Portable fundus camera image — 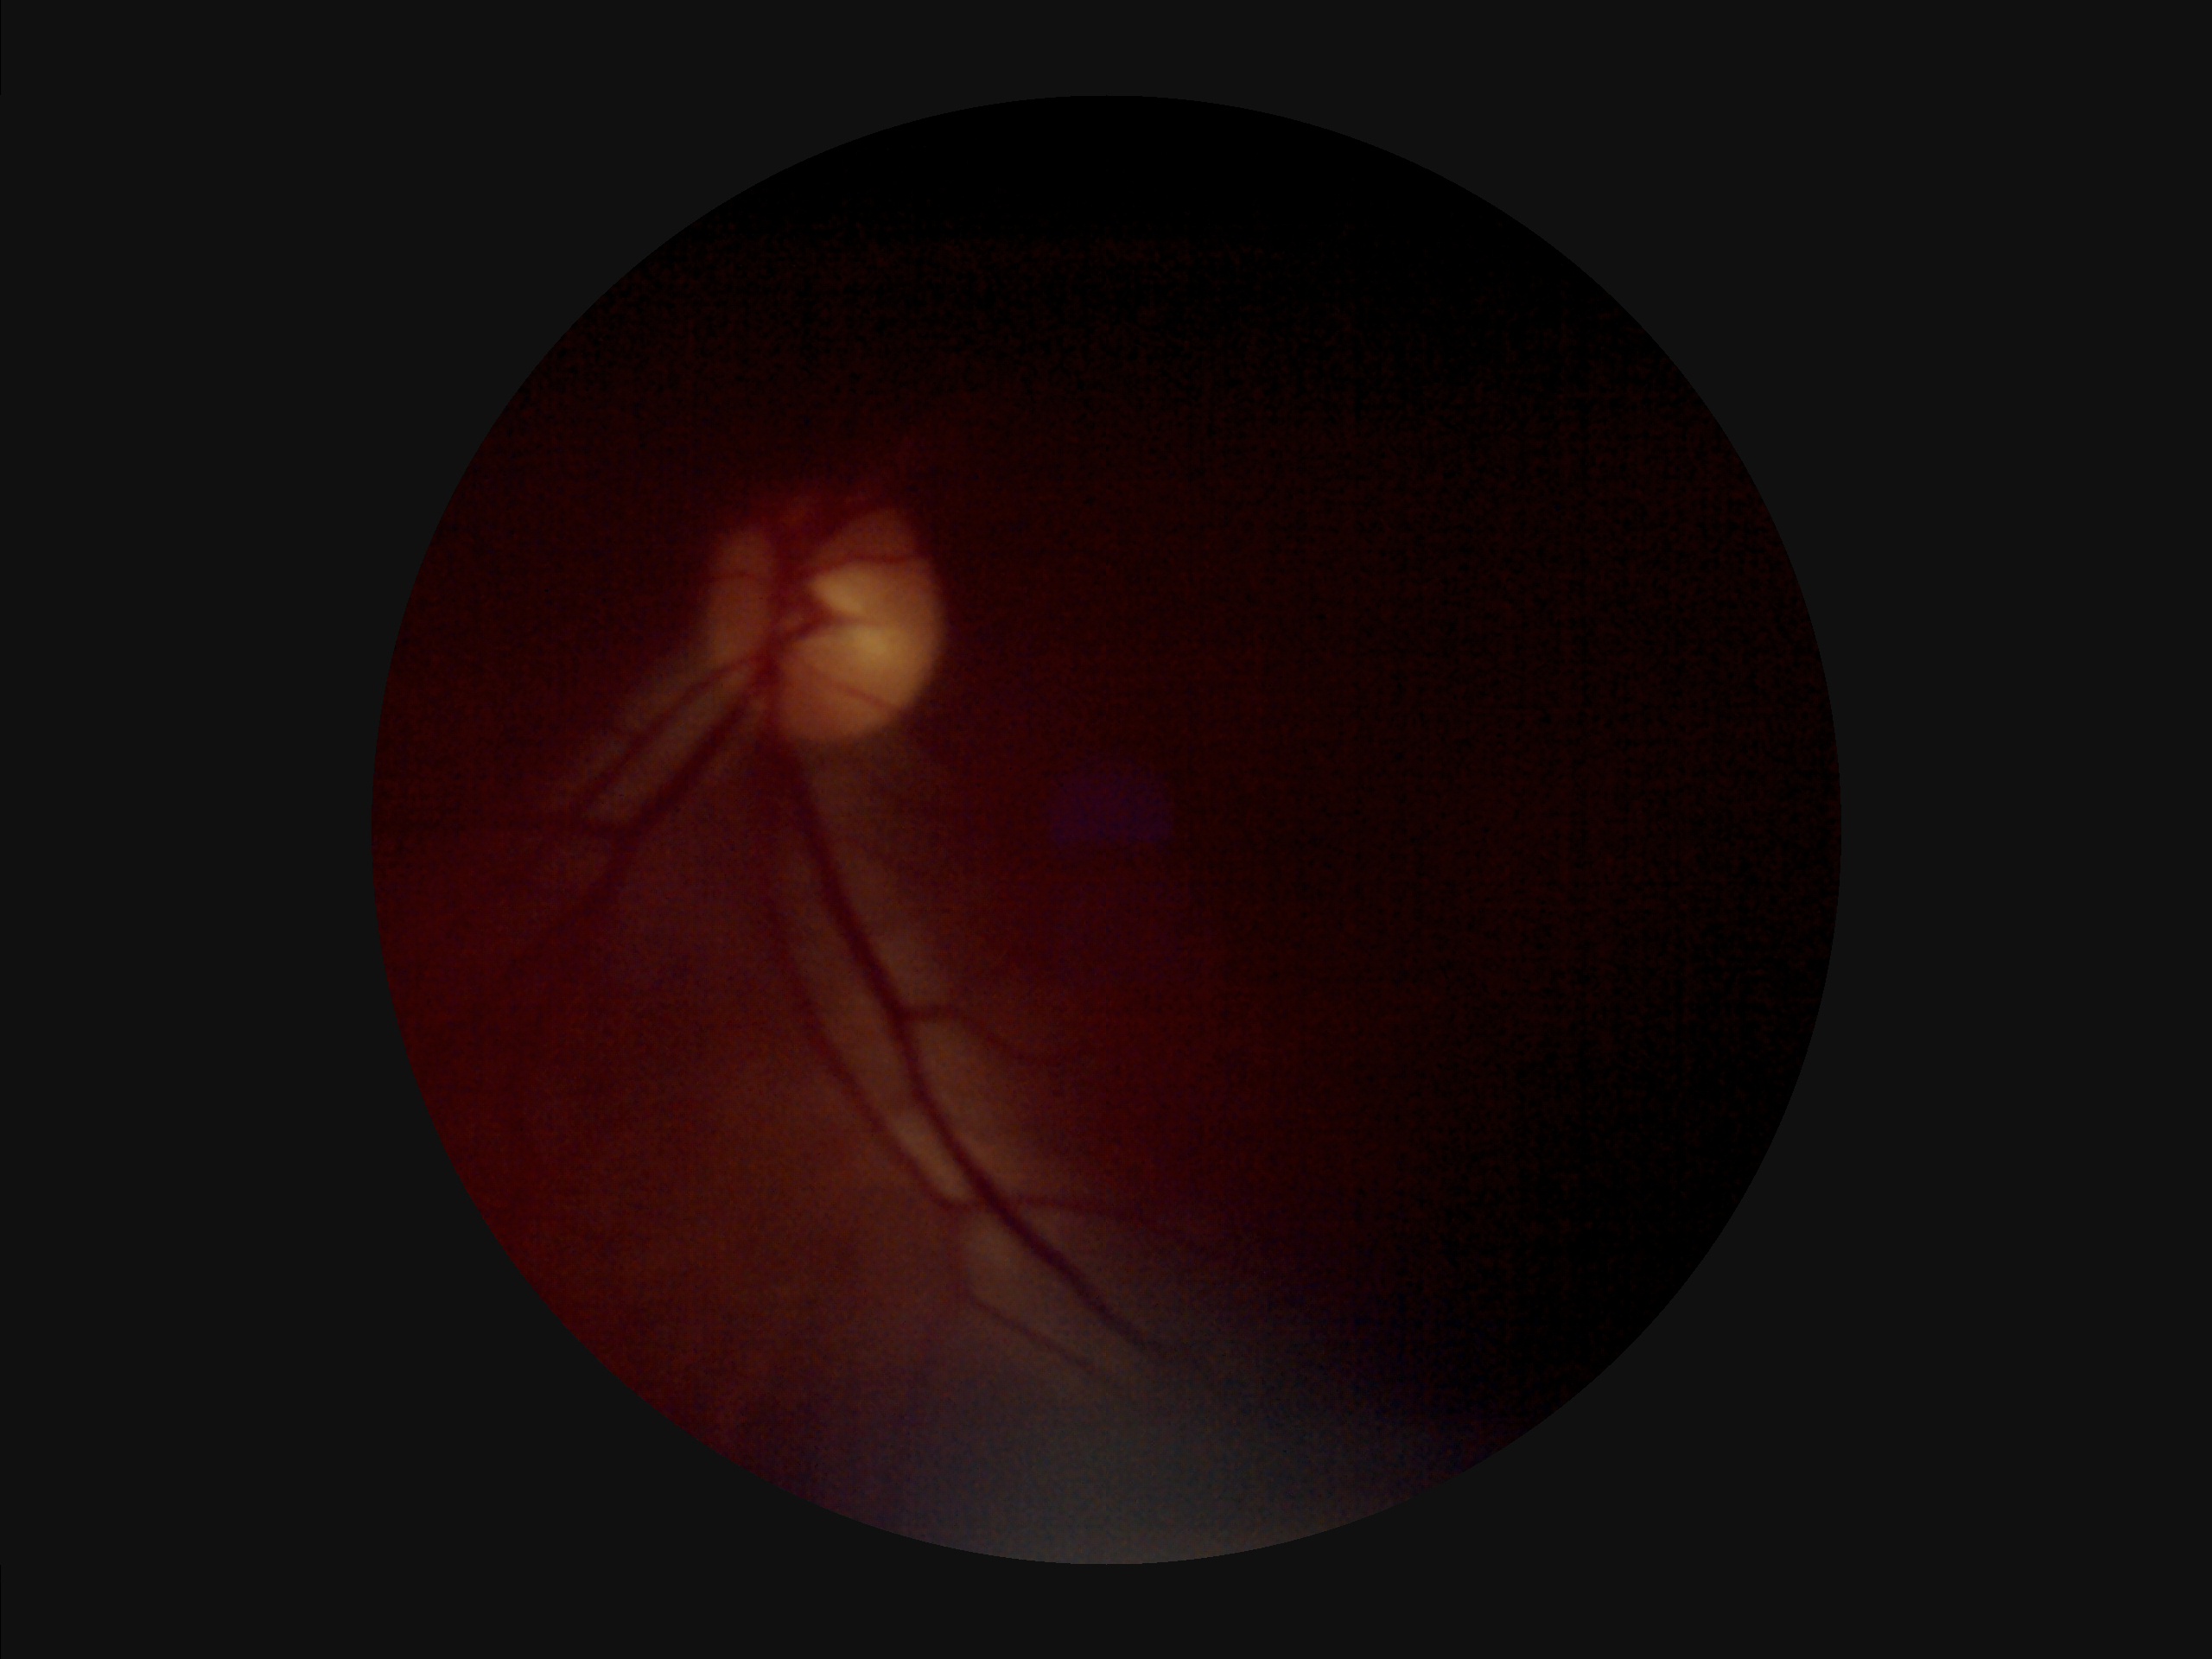 Image quality assessment: overall: poor and difficult to use diagnostically | contrast: poor dynamic range | illumination: uneven illumination or color cast | clarity: noticeable blur in the optic disc, vessels, or background.